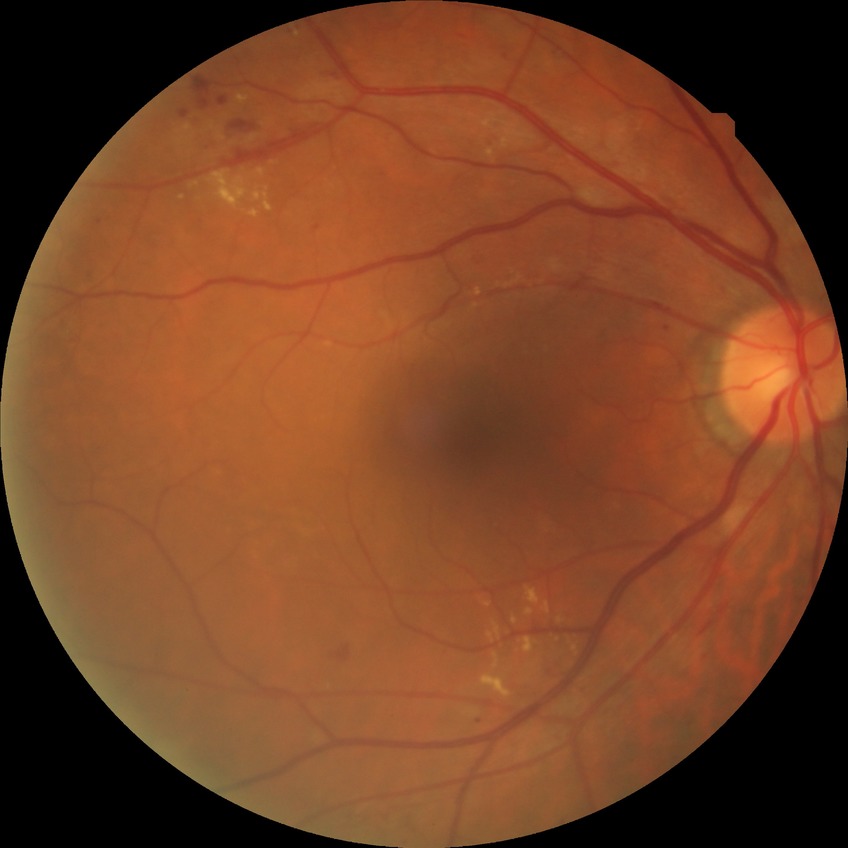

DR class: non-proliferative diabetic retinopathy
diabetic retinopathy (DR): SDR (simple diabetic retinopathy)